45 degree fundus photograph
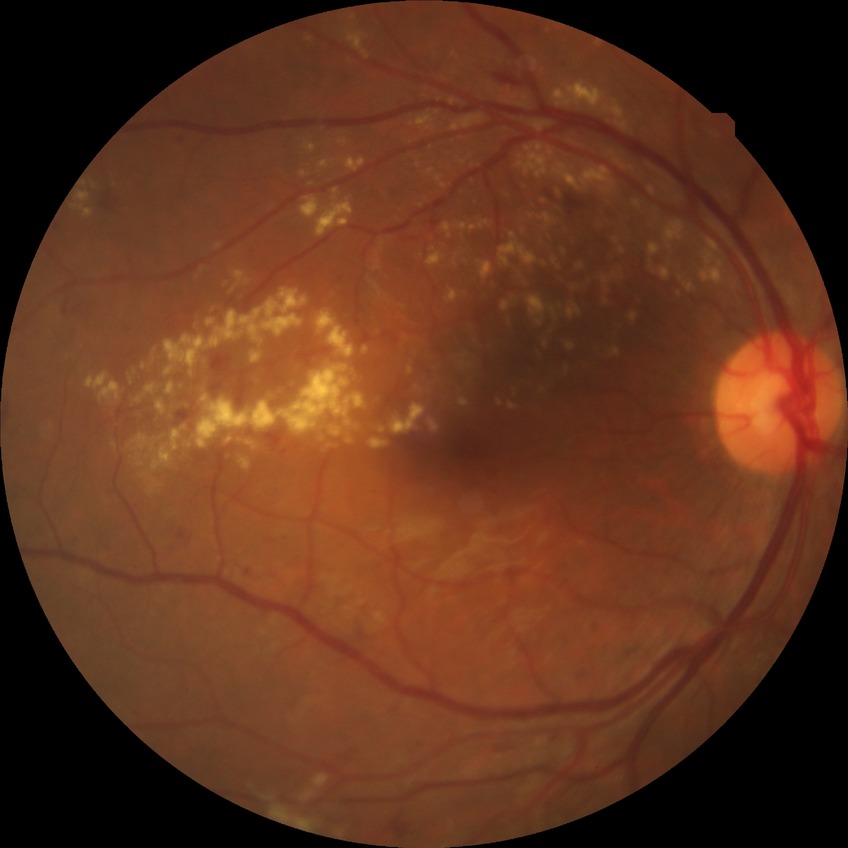 {"davis_grade": "pre-proliferative diabetic retinopathy"}